Captured with the Clarity RetCam 3 (130° field of view). Wide-field fundus photograph of an infant. 640 x 480 pixels:
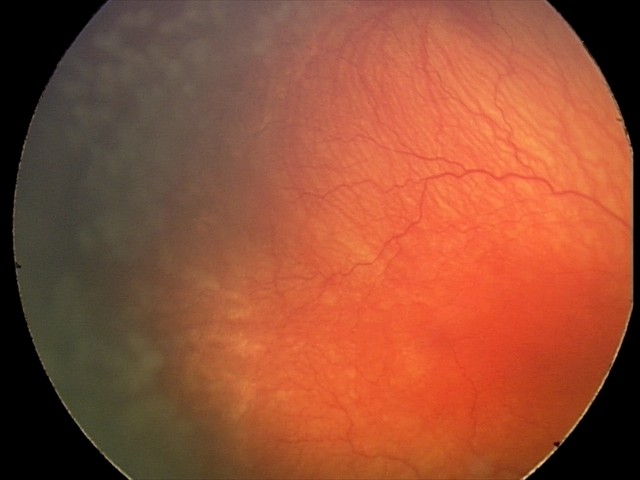 Q: What is the diagnosis from this examination?
A: aggressive retinopathy of prematurity